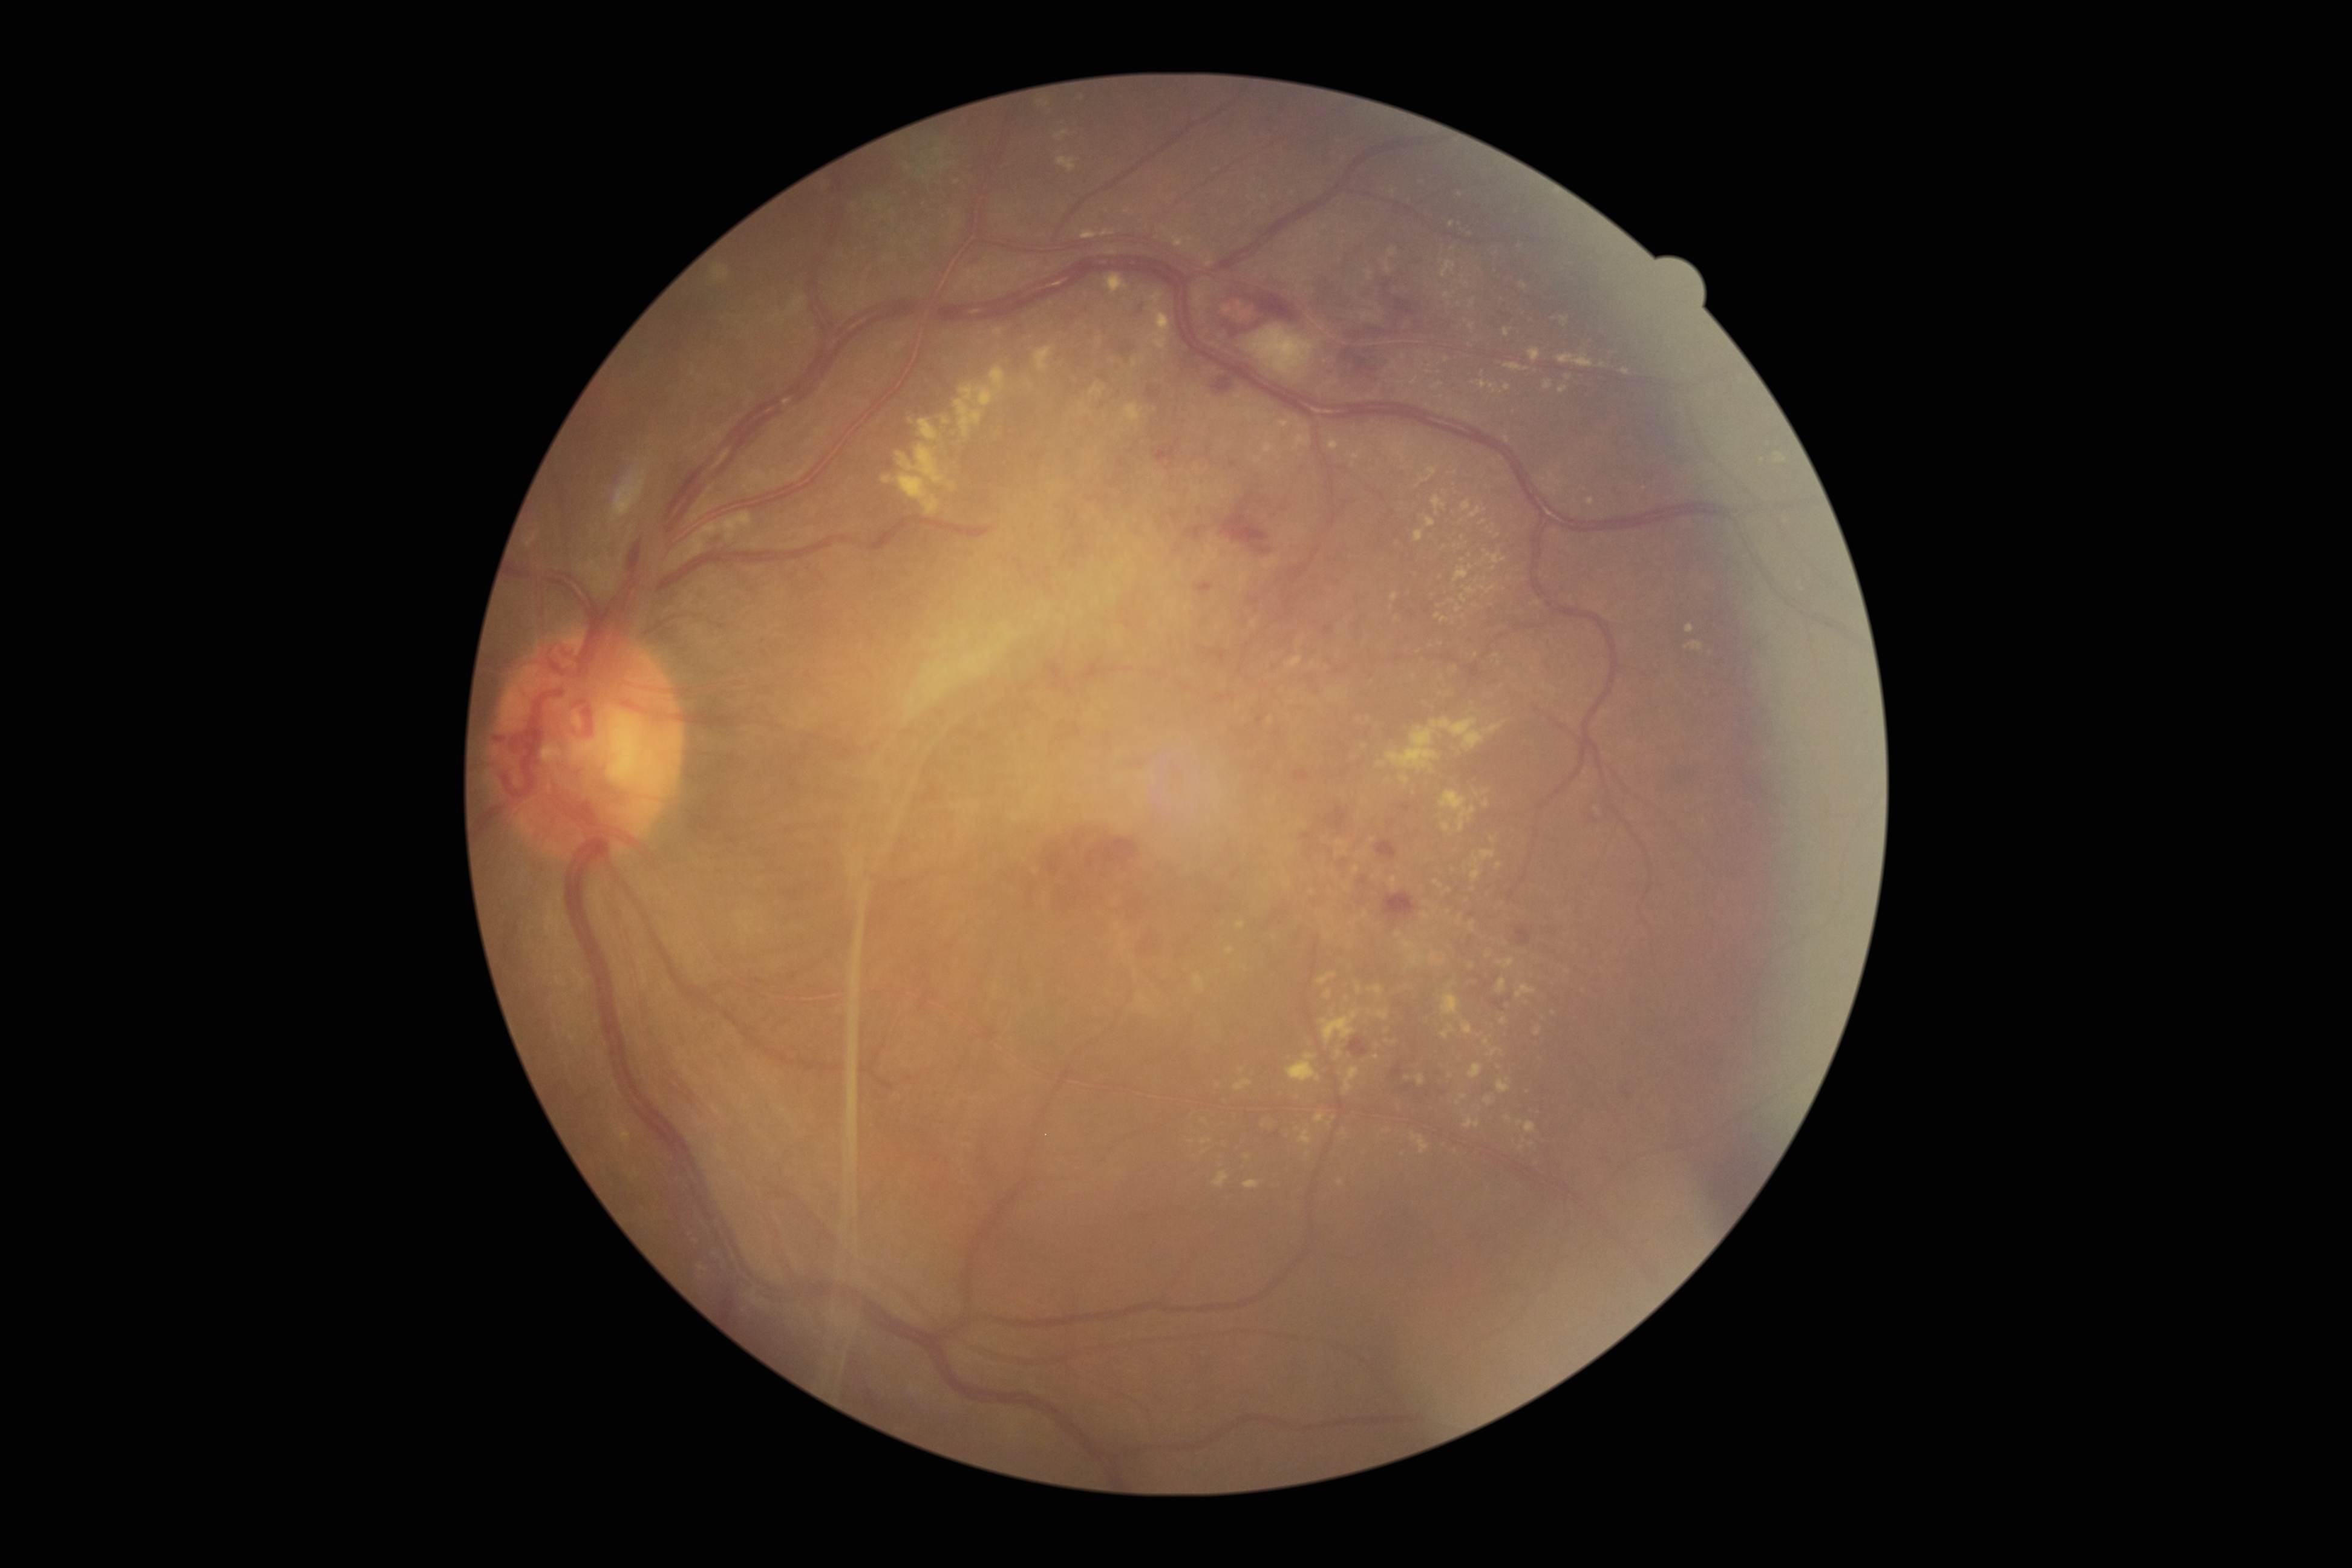 DR is 4/4. EXs (partial list) at x1=1484, y1=1037, x2=1489, y2=1047, x1=1461, y1=1021, x2=1474, y2=1035, x1=1524, y1=1121, x2=1535, y2=1132, x1=1425, y1=517, x2=1434, y2=527, x1=1206, y1=257, x2=1213, y2=268, x1=1057, y1=157, x2=1077, y2=172, x1=1465, y1=1117, x2=1479, y2=1128, x1=1486, y1=953, x2=1494, y2=959, x1=1386, y1=264, x2=1392, y2=274, x1=1034, y1=348, x2=1056, y2=371, x1=1328, y1=691, x2=1339, y2=697, x1=1468, y1=1063, x2=1483, y2=1079. Small EXs near [1399,934], [1366,915], [1567,971], [1394,1042], [1447,360], [1265,197], [1439,616].